CFP
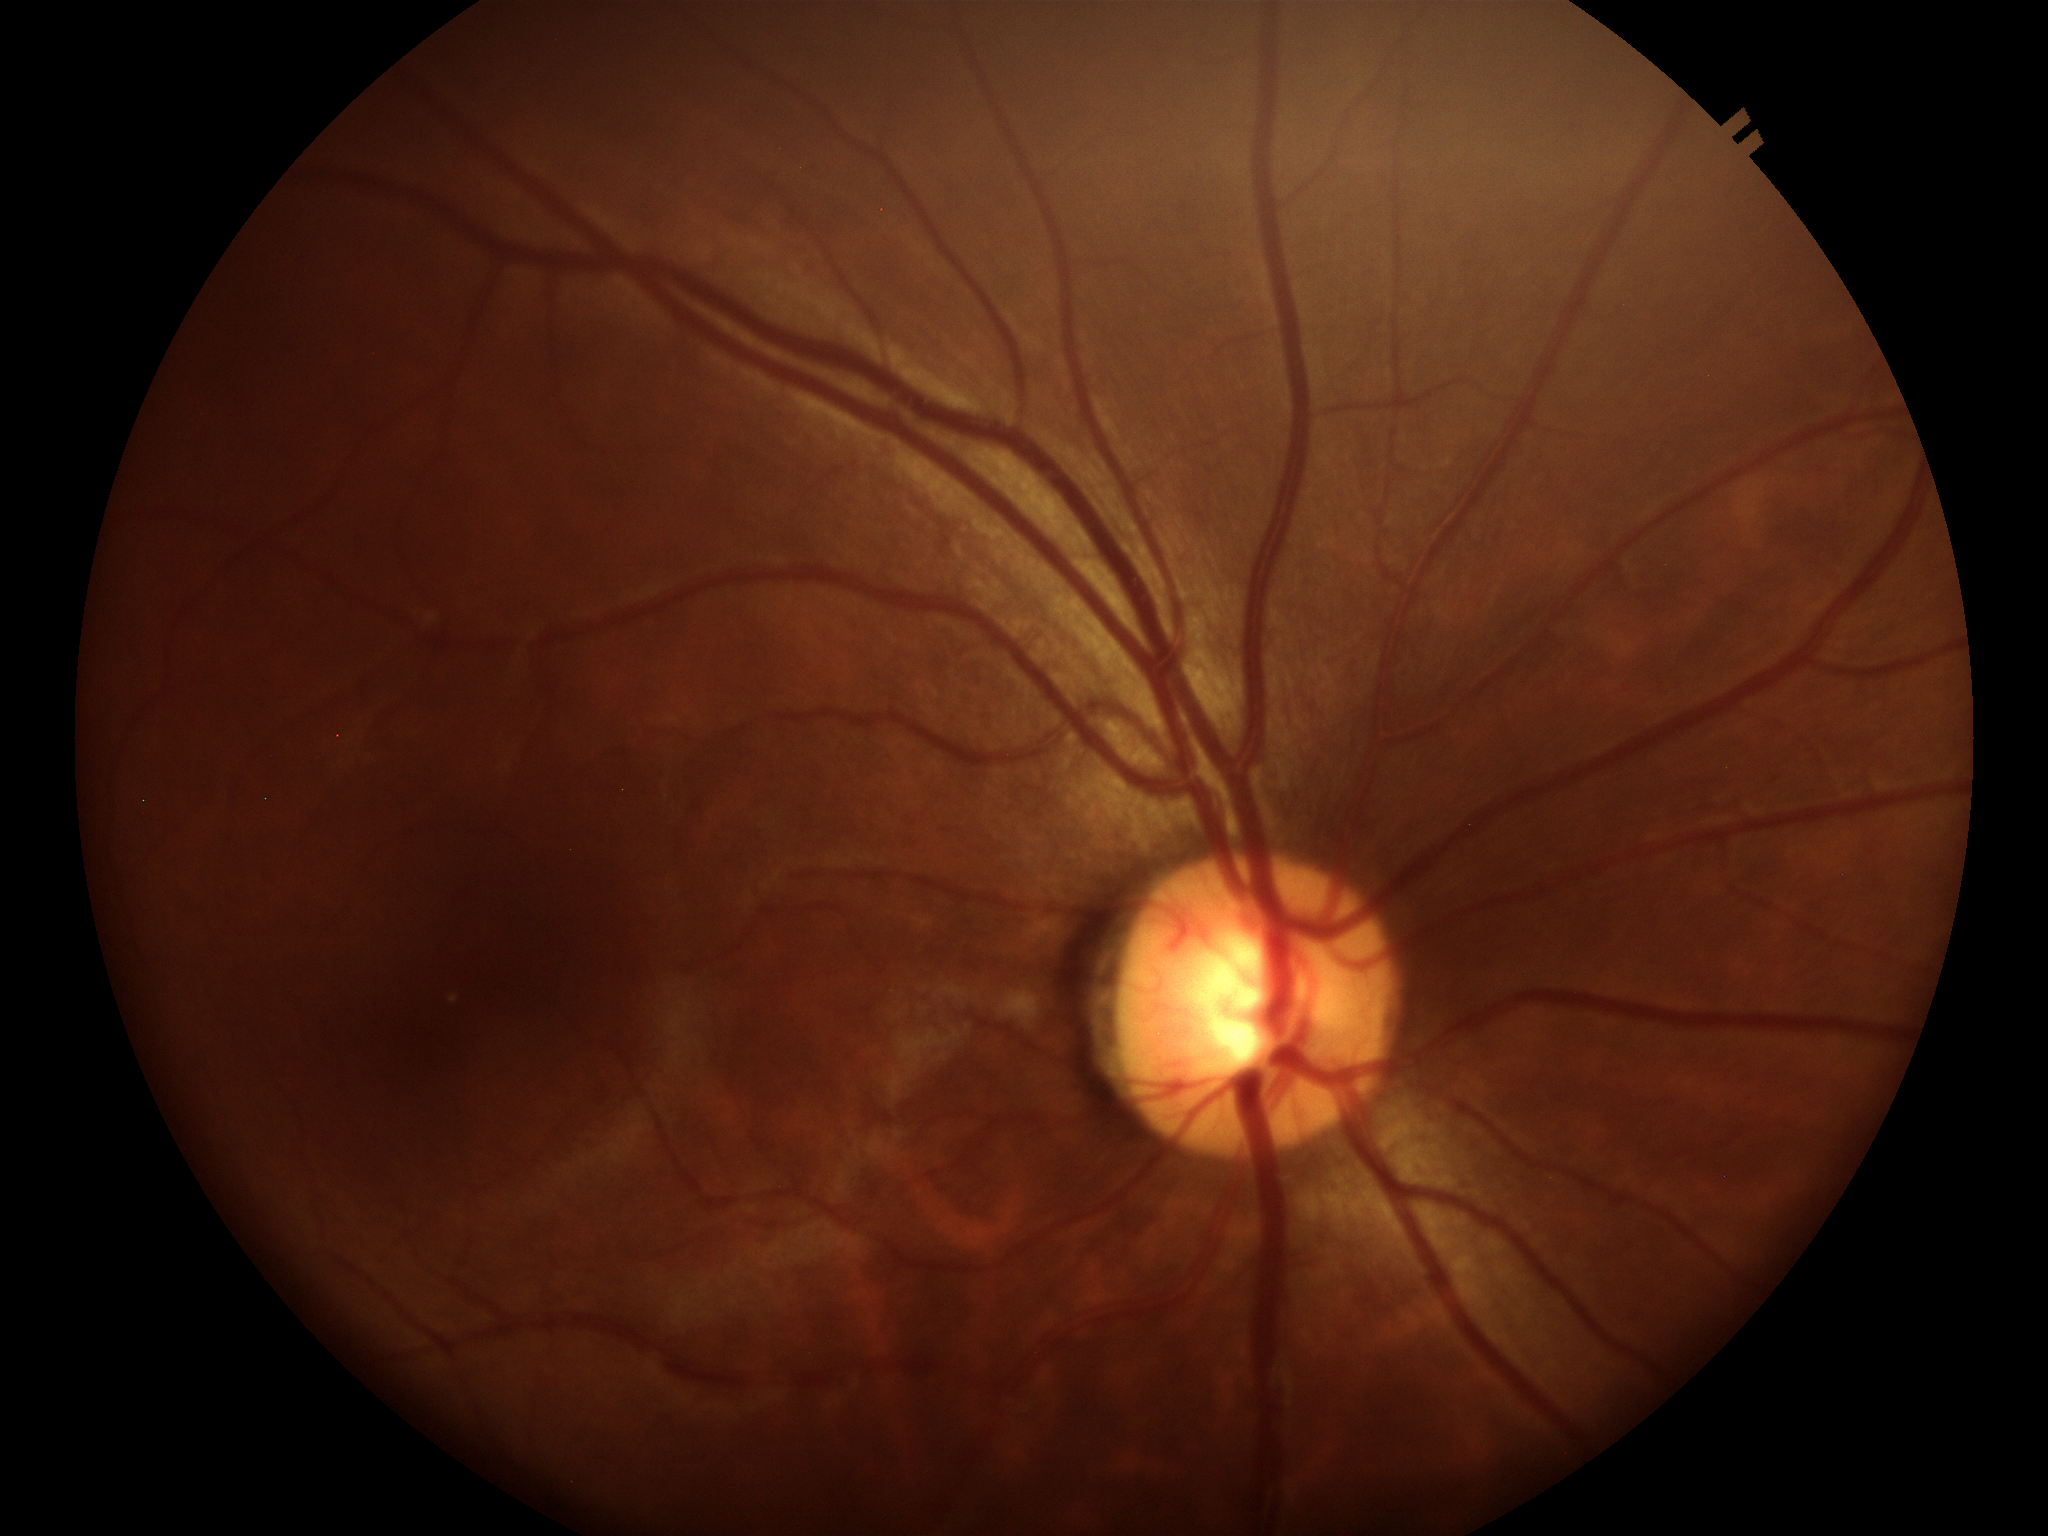 - Glaucoma screening · not suspect
- vertical cup-disc ratio · 0.51